FOV: 45 degrees · 2352x1568px · retinal fundus photograph:
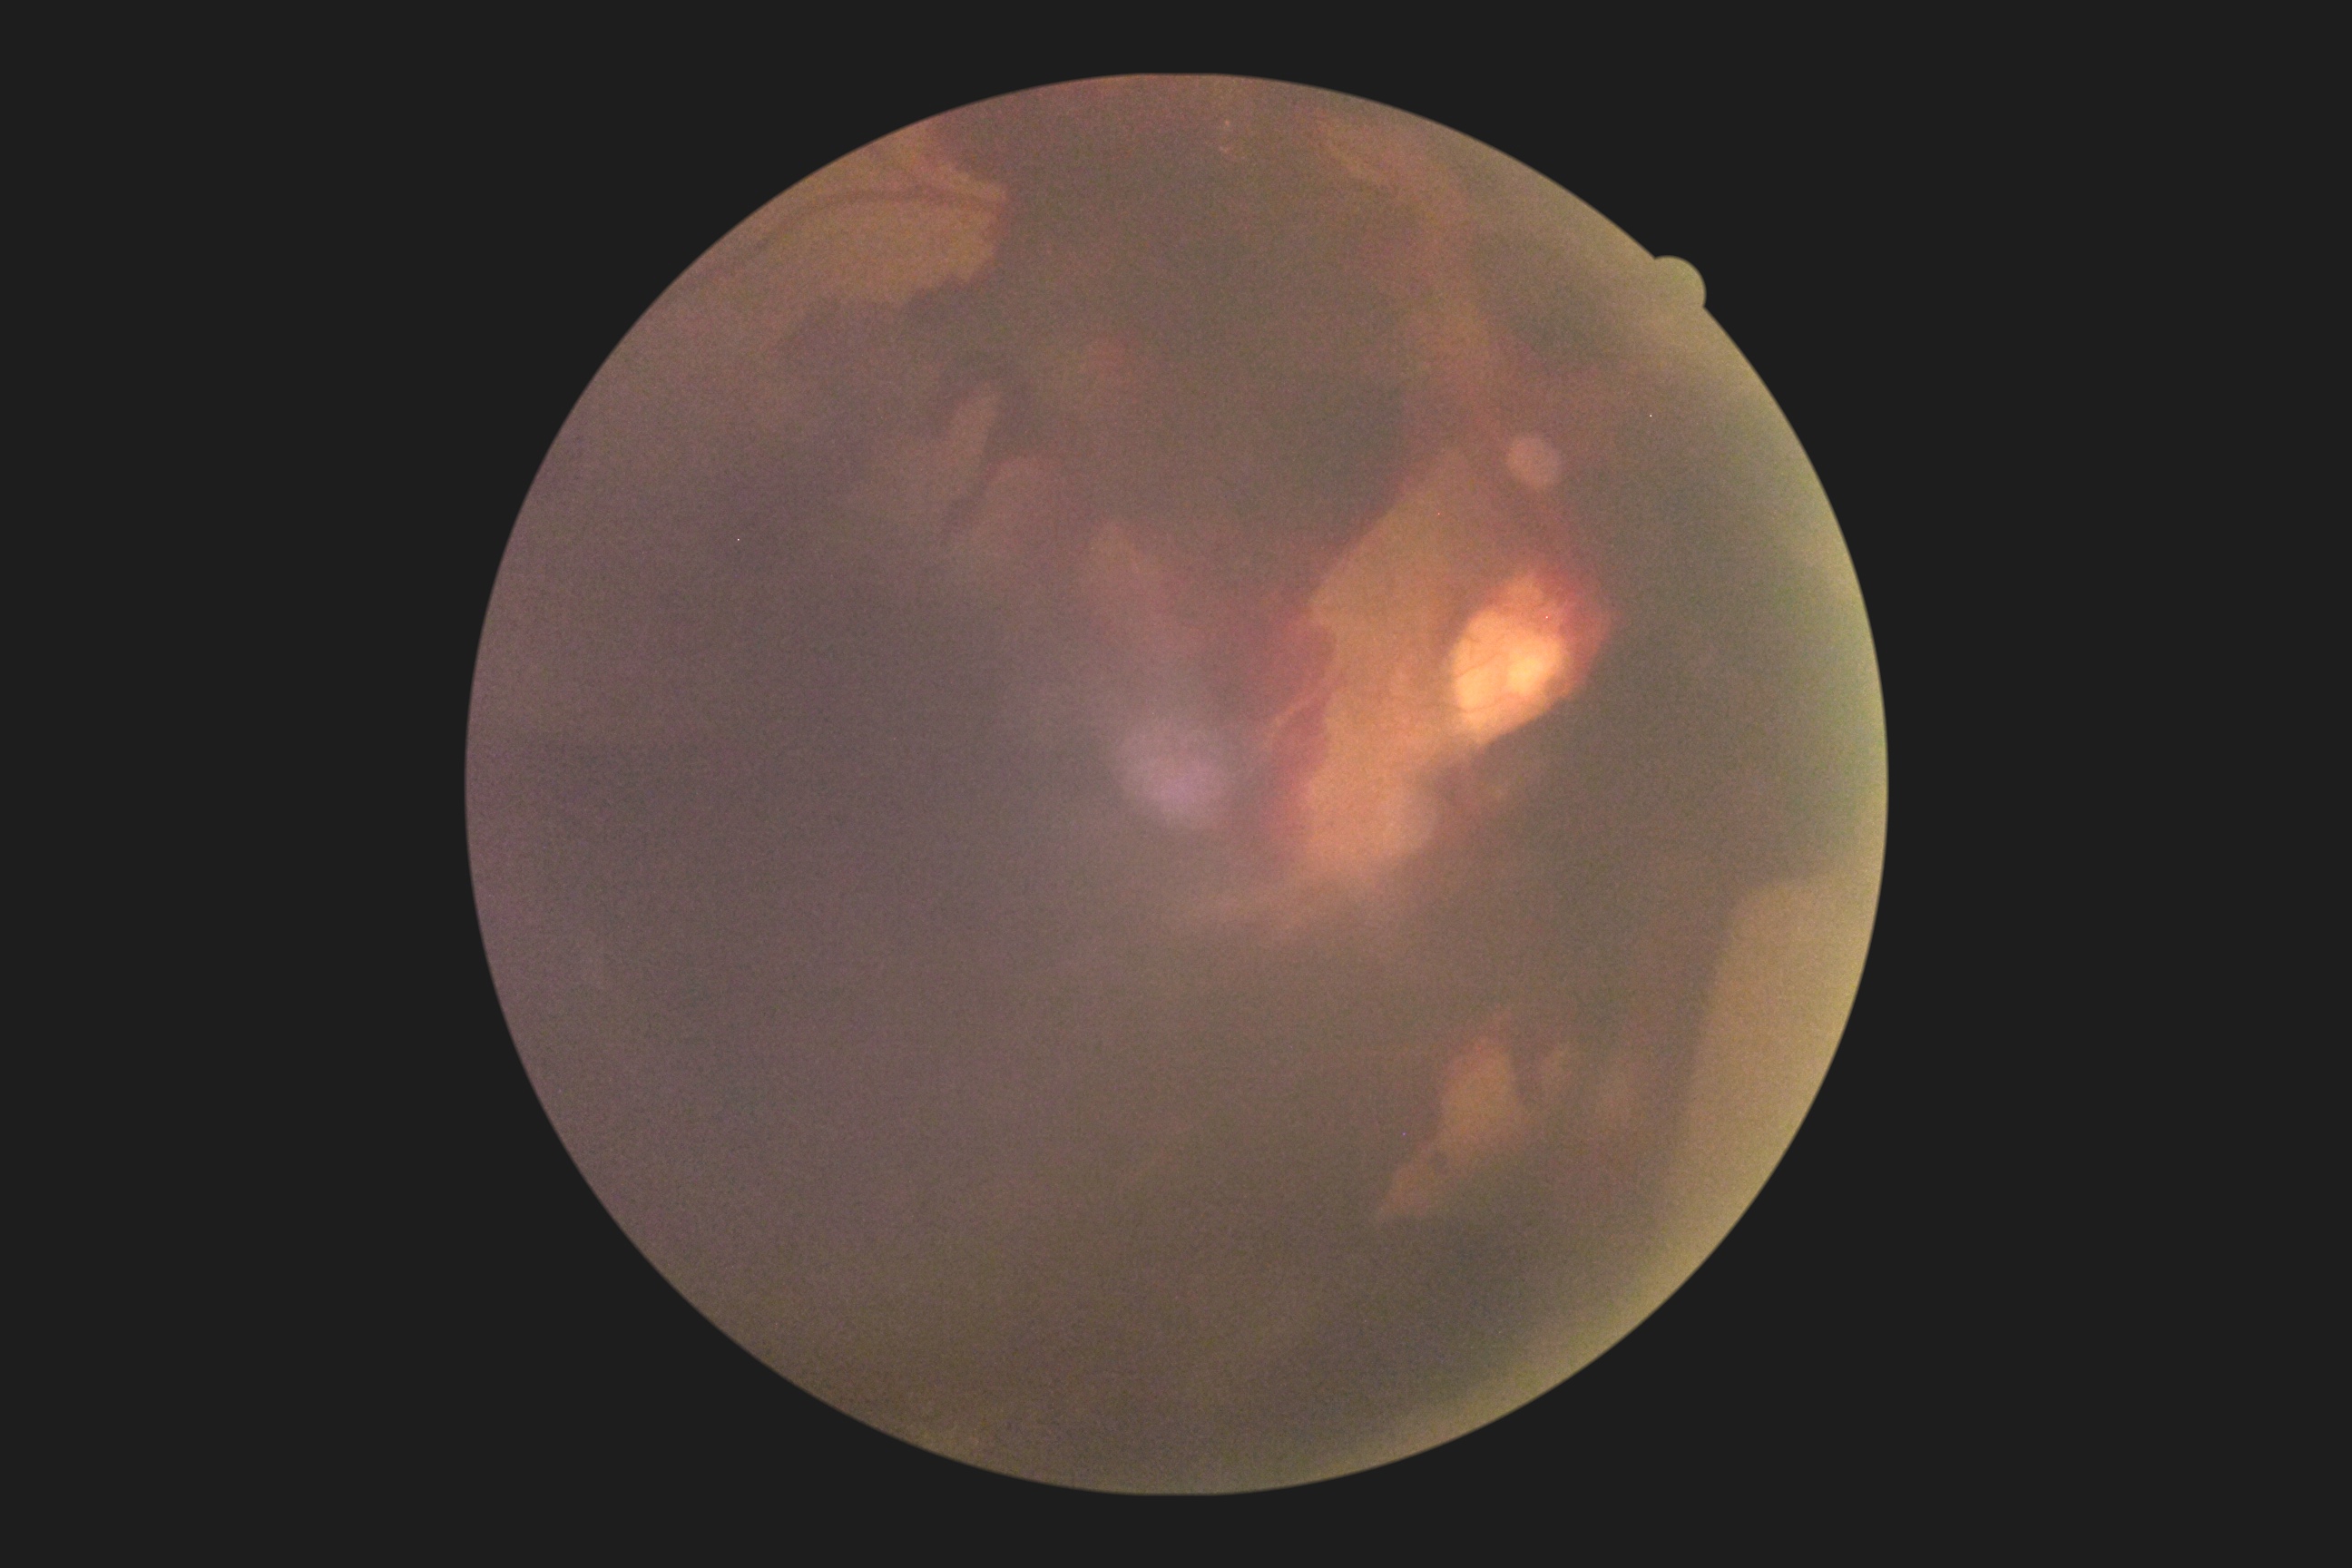
Diabetic retinopathy (DR) is PDR (grade 4) — neovascularization and/or vitreous/pre-retinal hemorrhage. The retinopathy is classified as proliferative diabetic retinopathy.